1440x1080px. Wide-field fundus photograph of an infant: 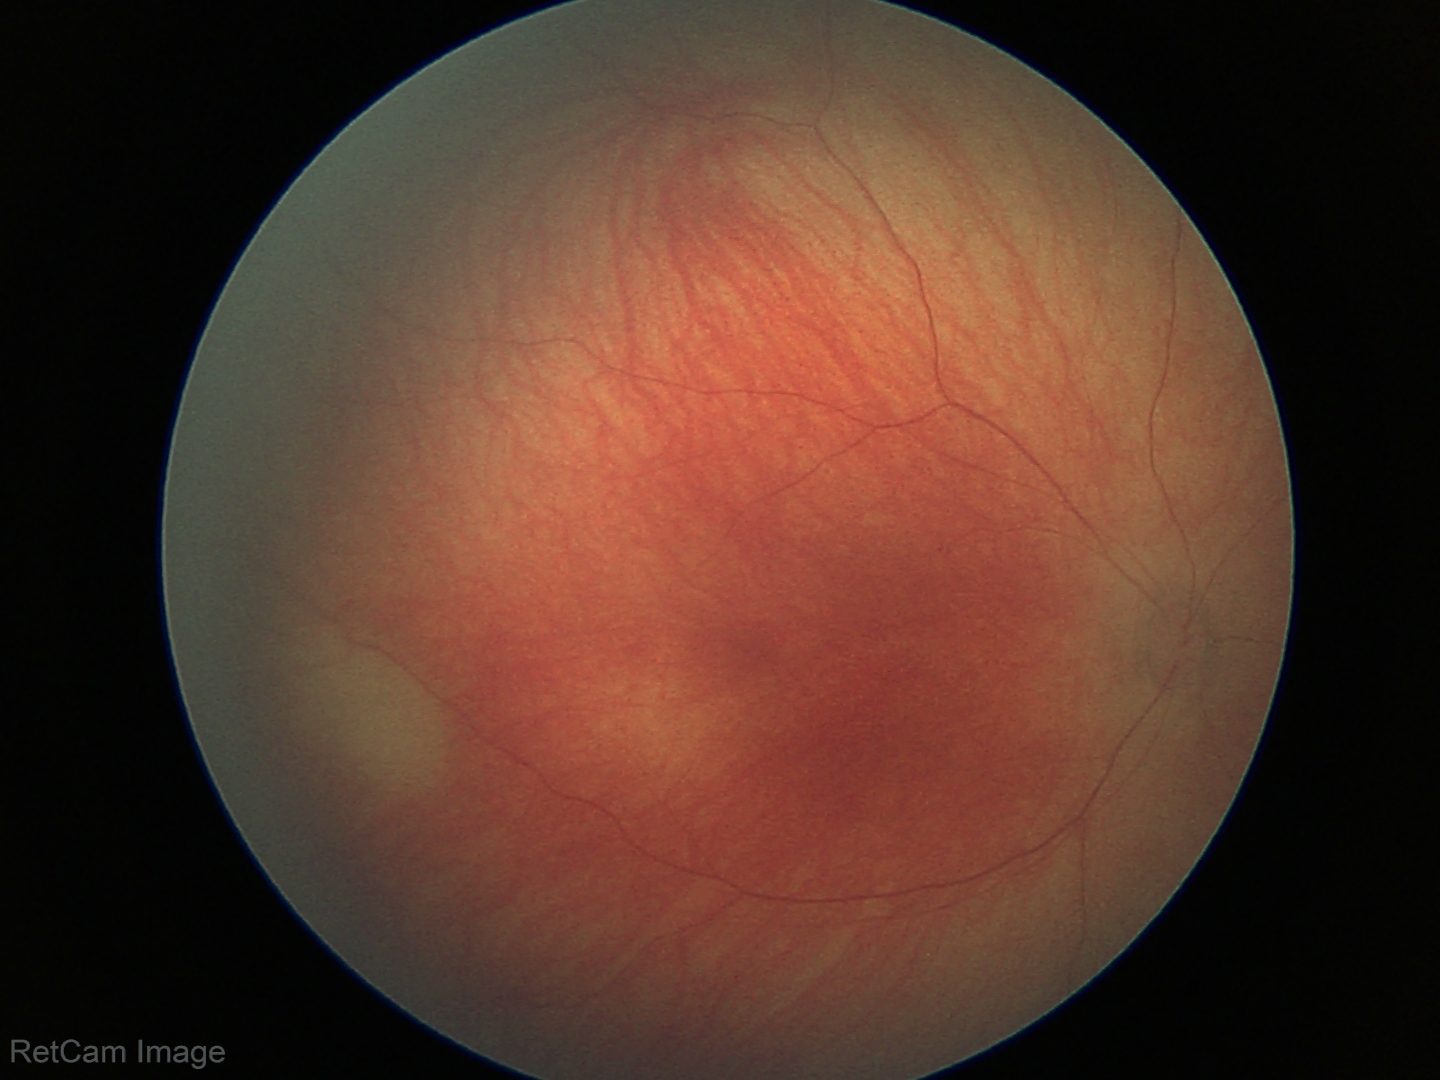 Screening examination with no abnormal retinal findings.